FOV: 45 degrees. Color fundus photograph. 1932 x 1932 pixels: 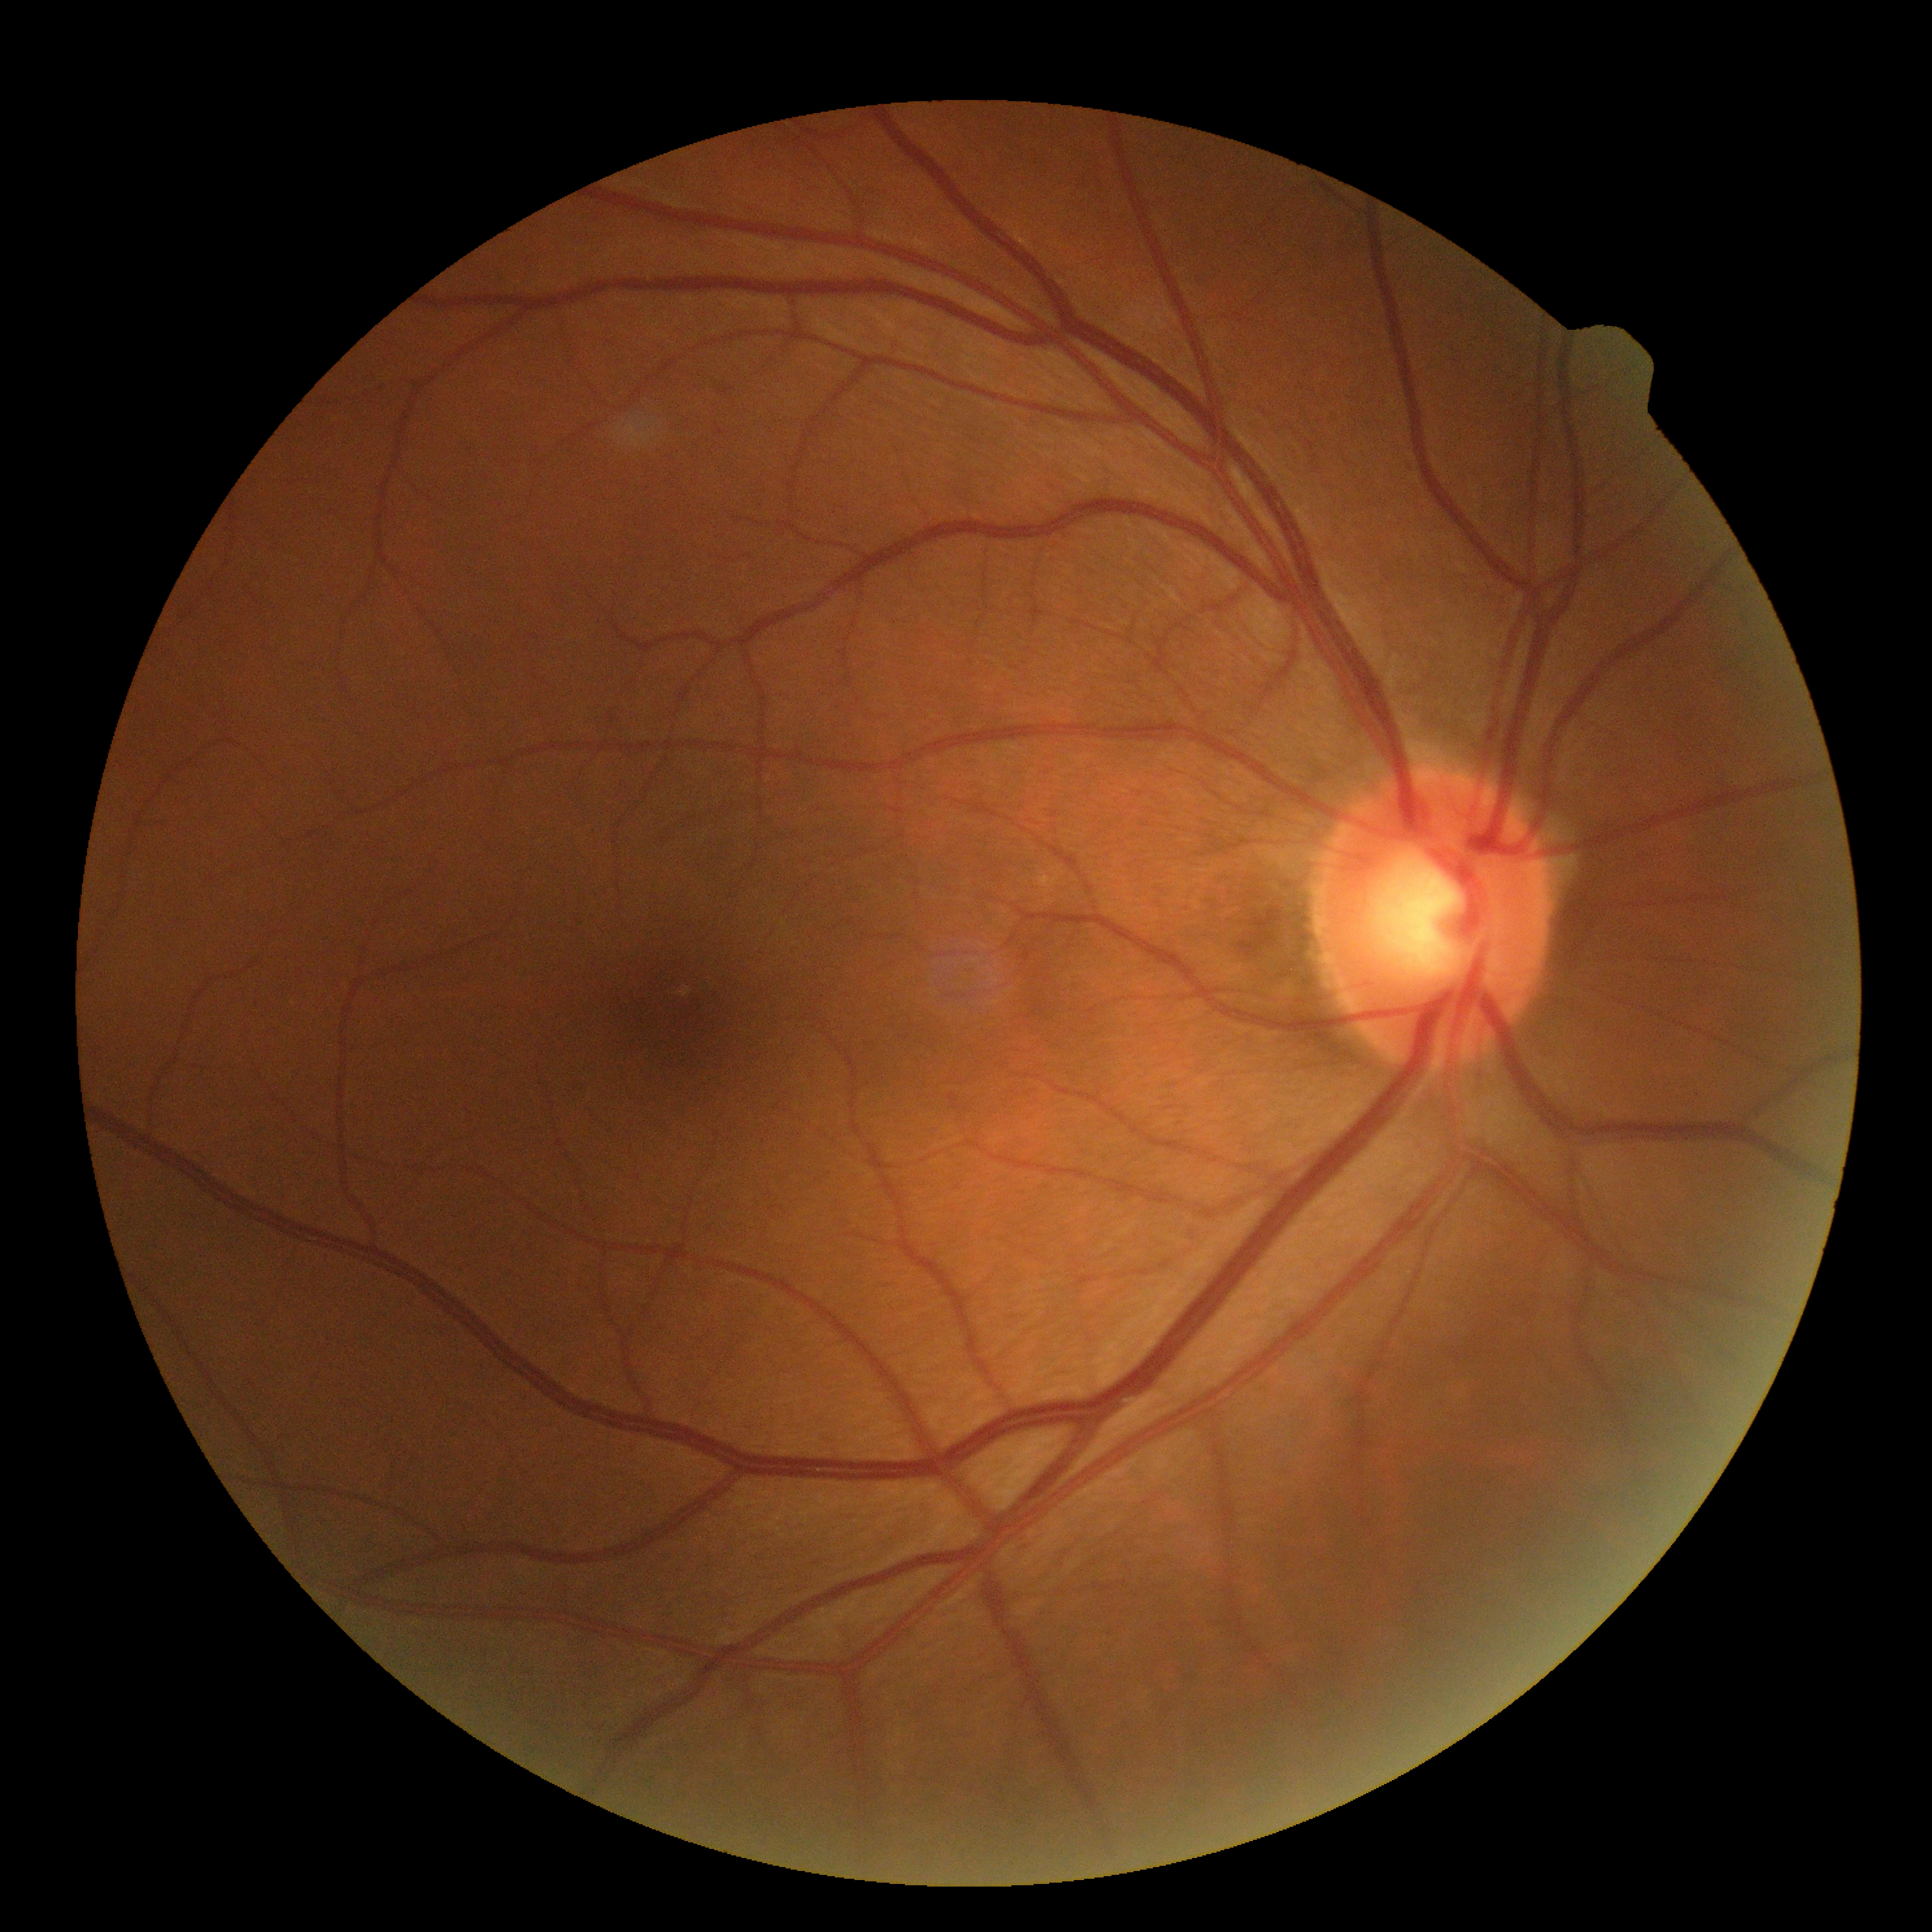 Retinopathy is grade 0 (no apparent retinopathy).